FOV: 45 degrees — 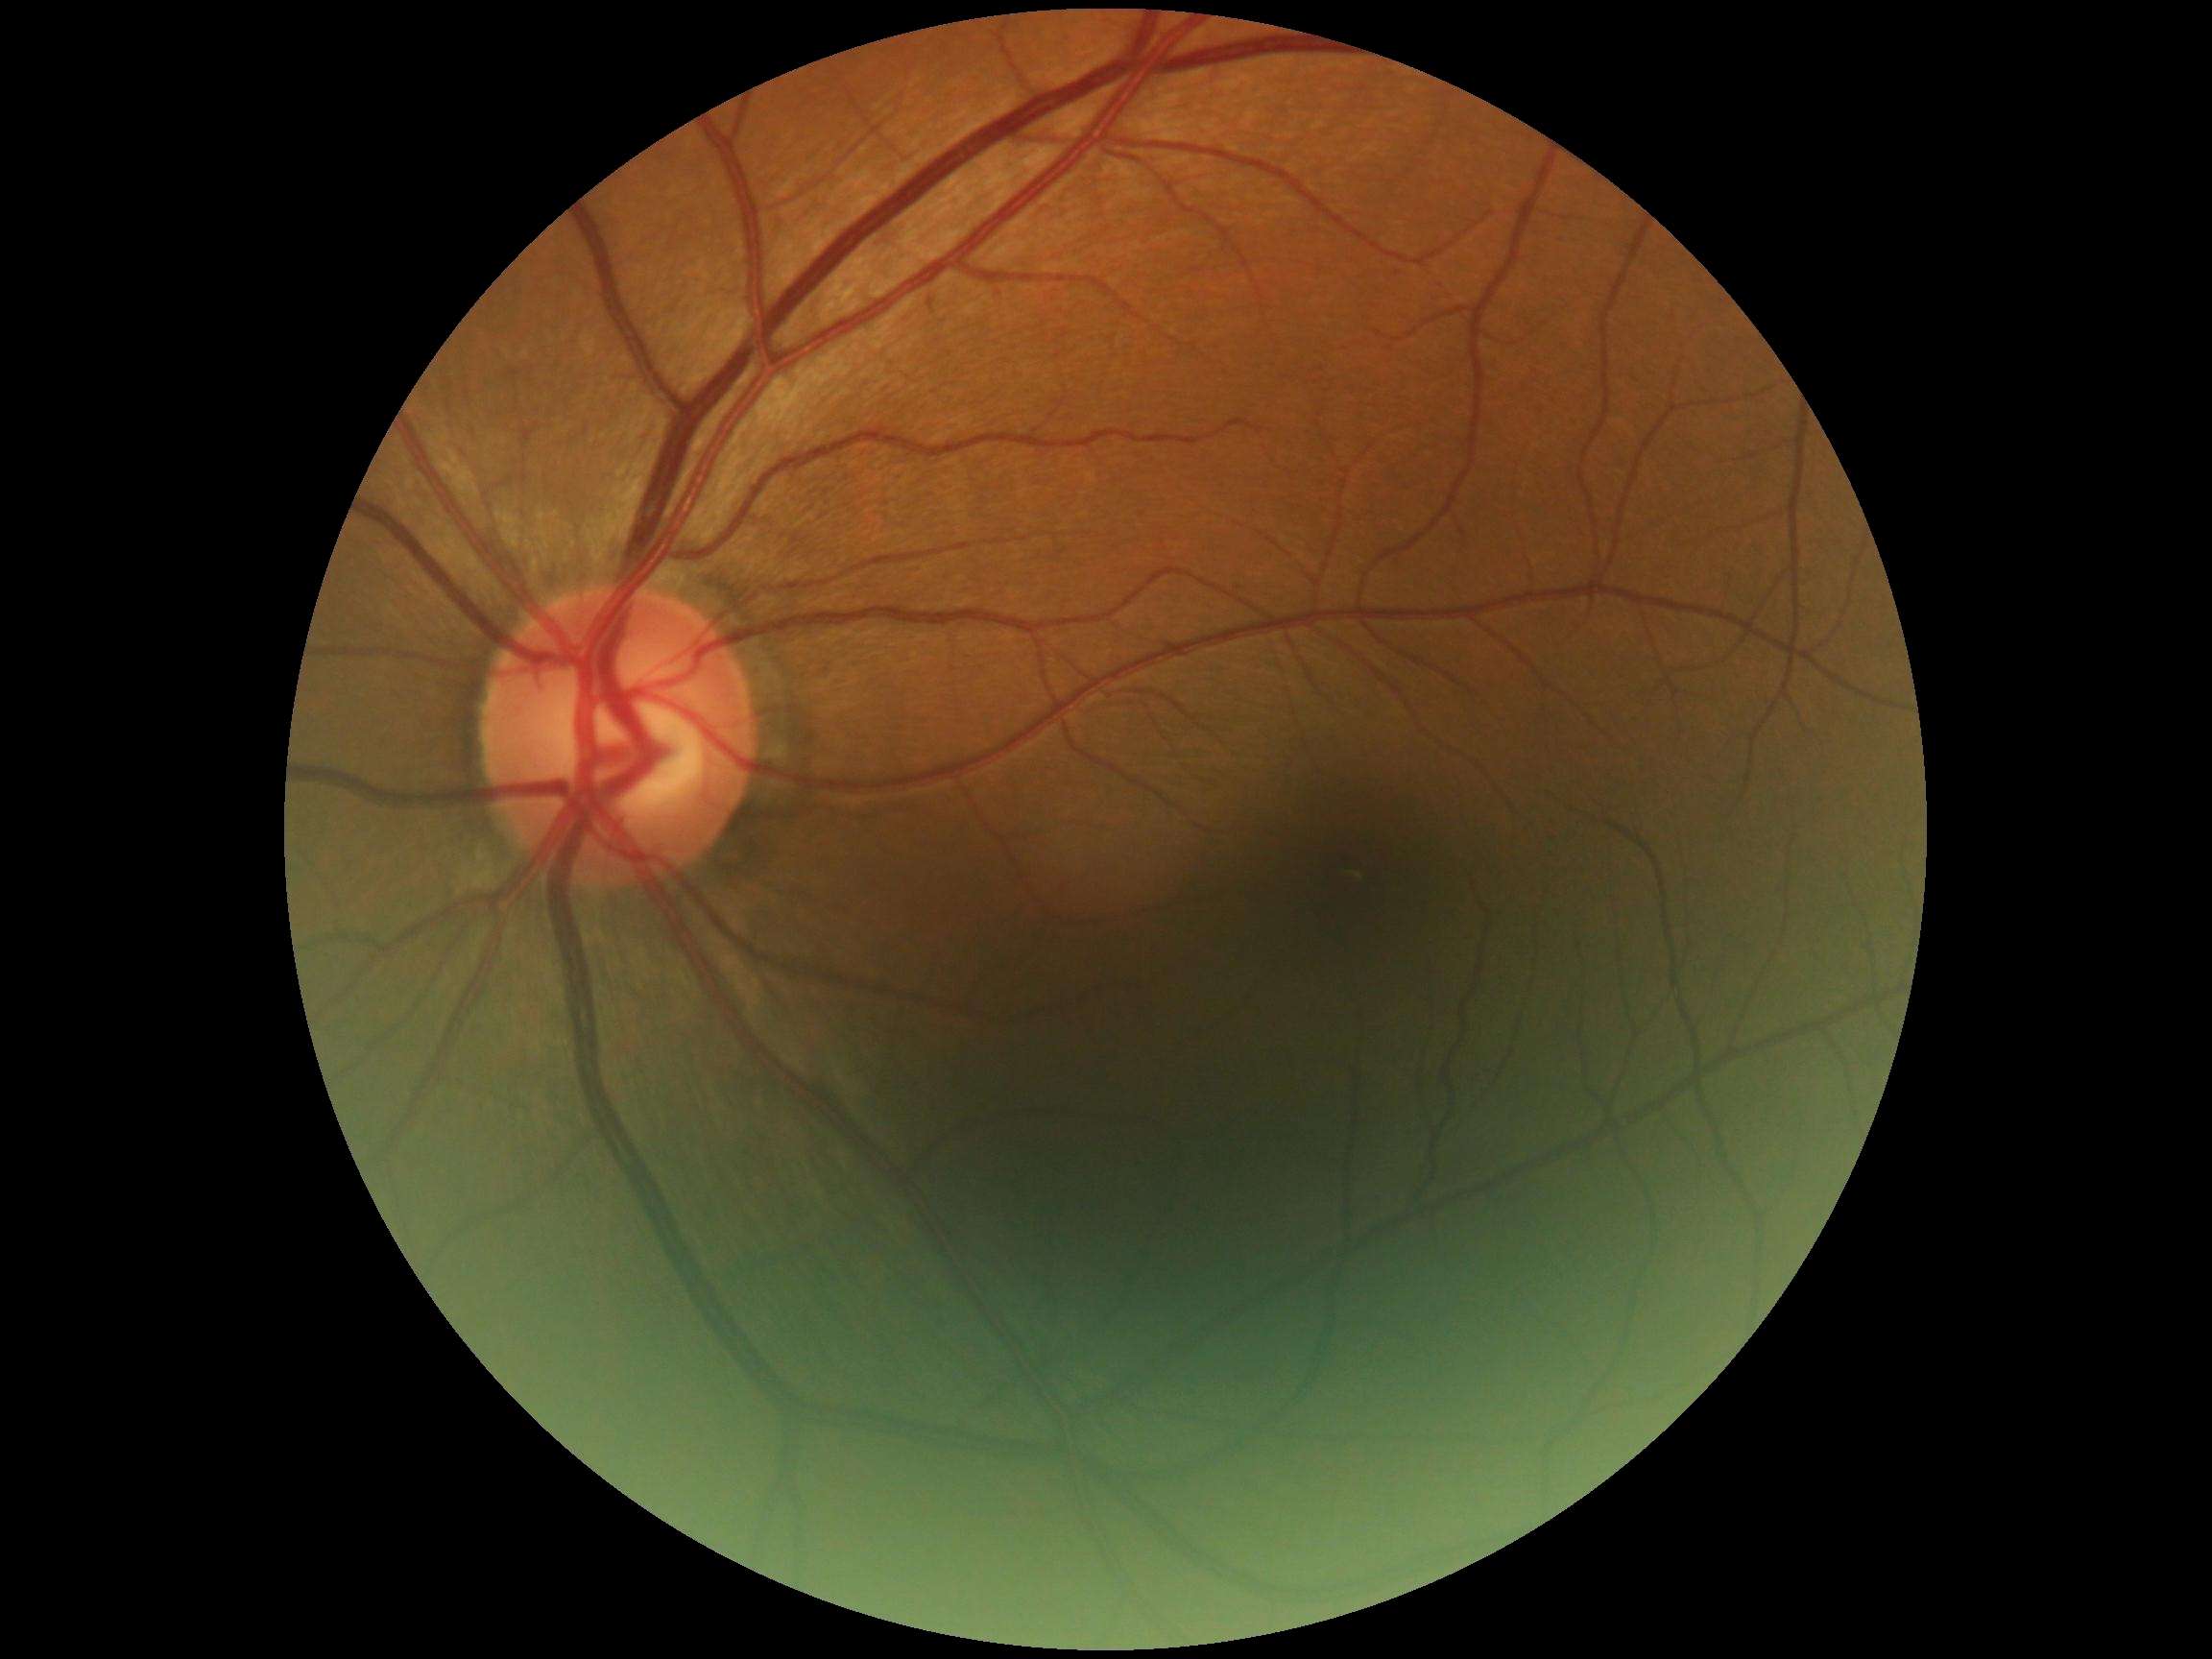
Annotations:
– diabetic retinopathy (DR) — 0/4